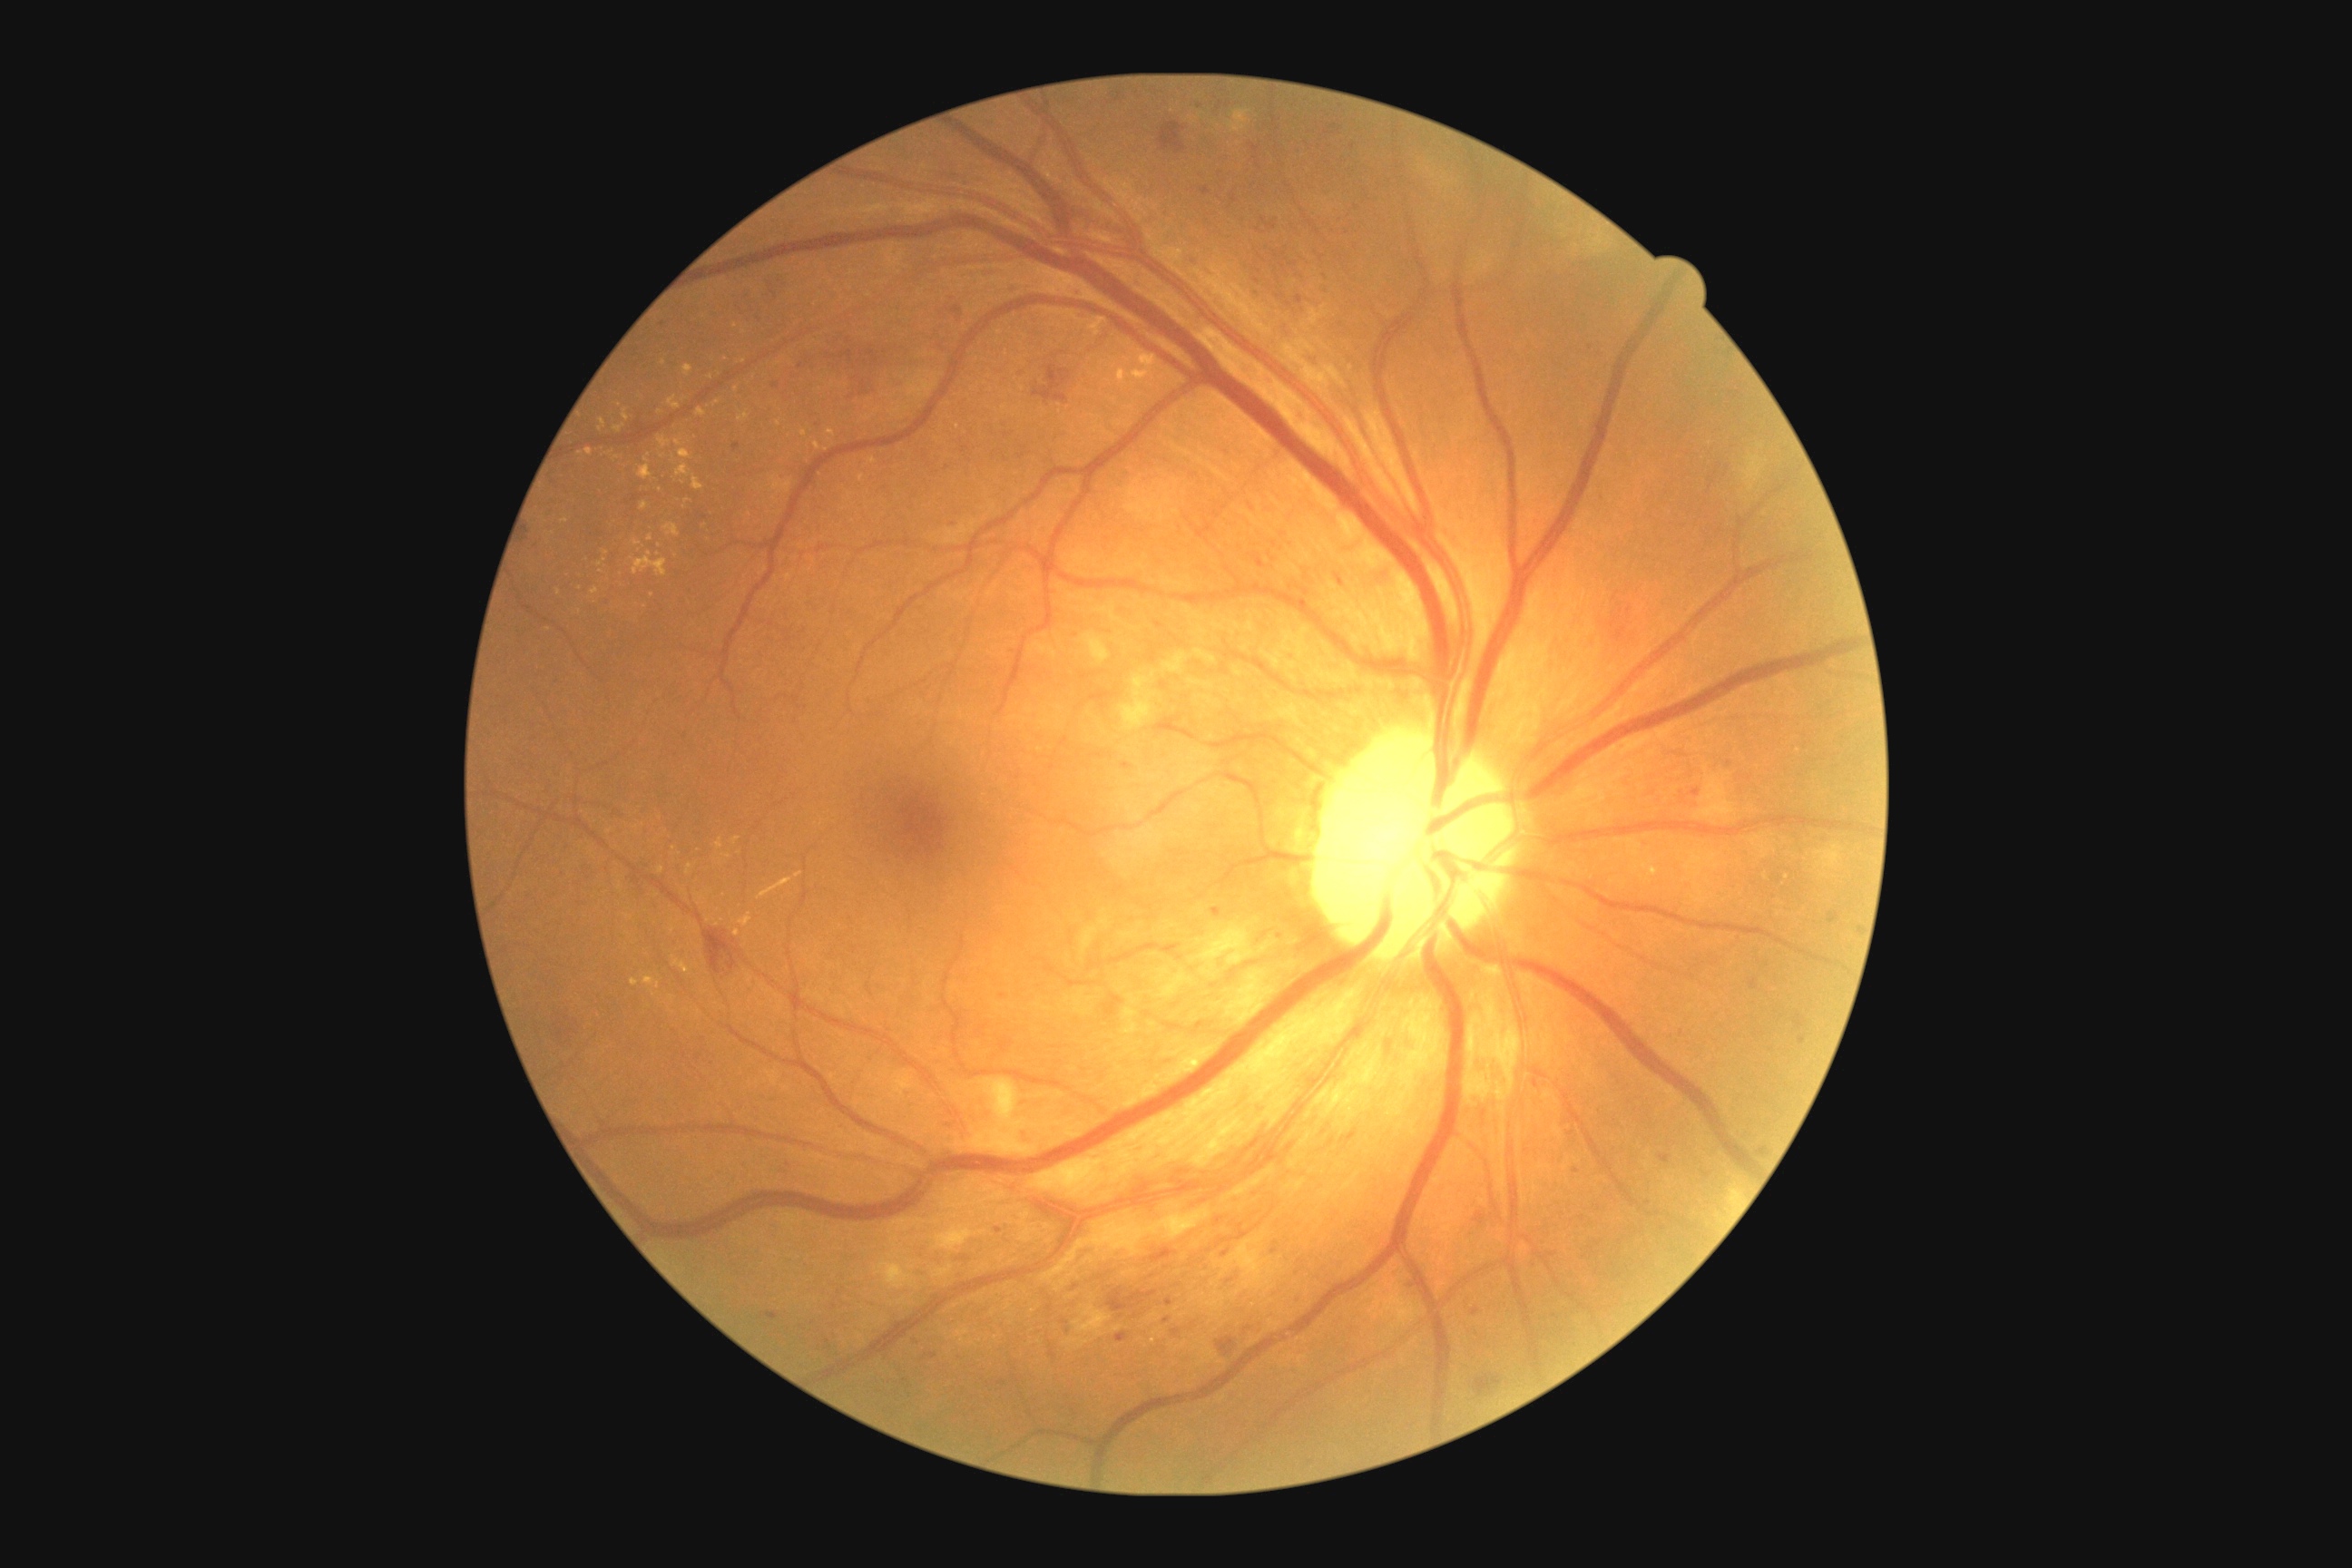

retinopathy@2, DR class@non-proliferative diabetic retinopathy.